CFP. Diabetic retinopathy graded by the modified Davis classification. 848x848px:
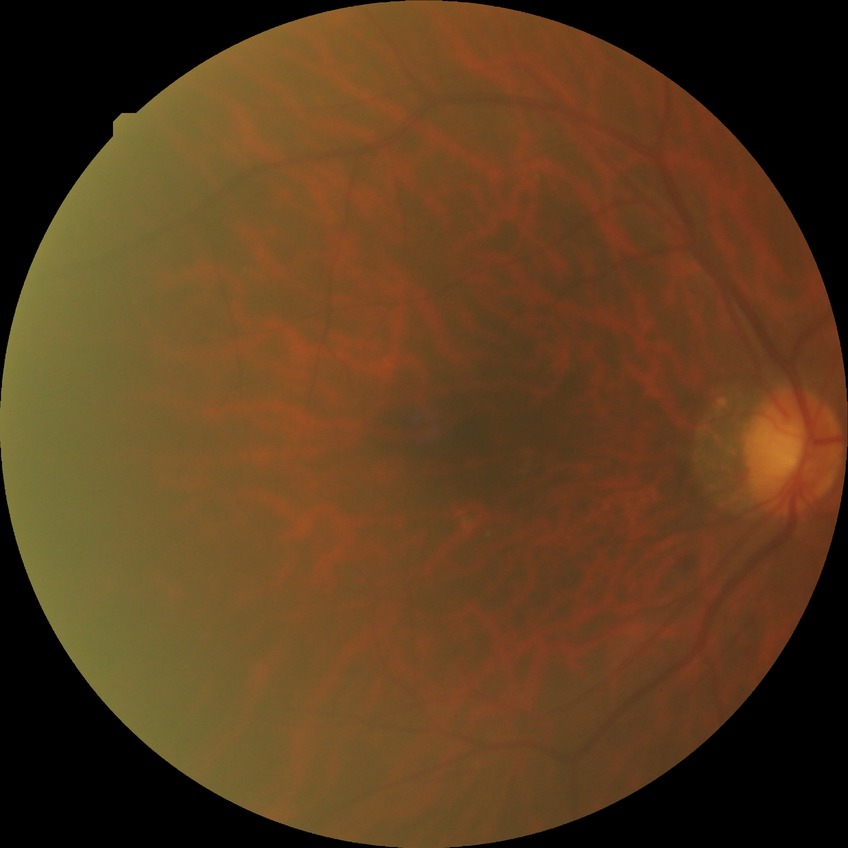
Diabetic retinopathy (DR) is NDR (no diabetic retinopathy).